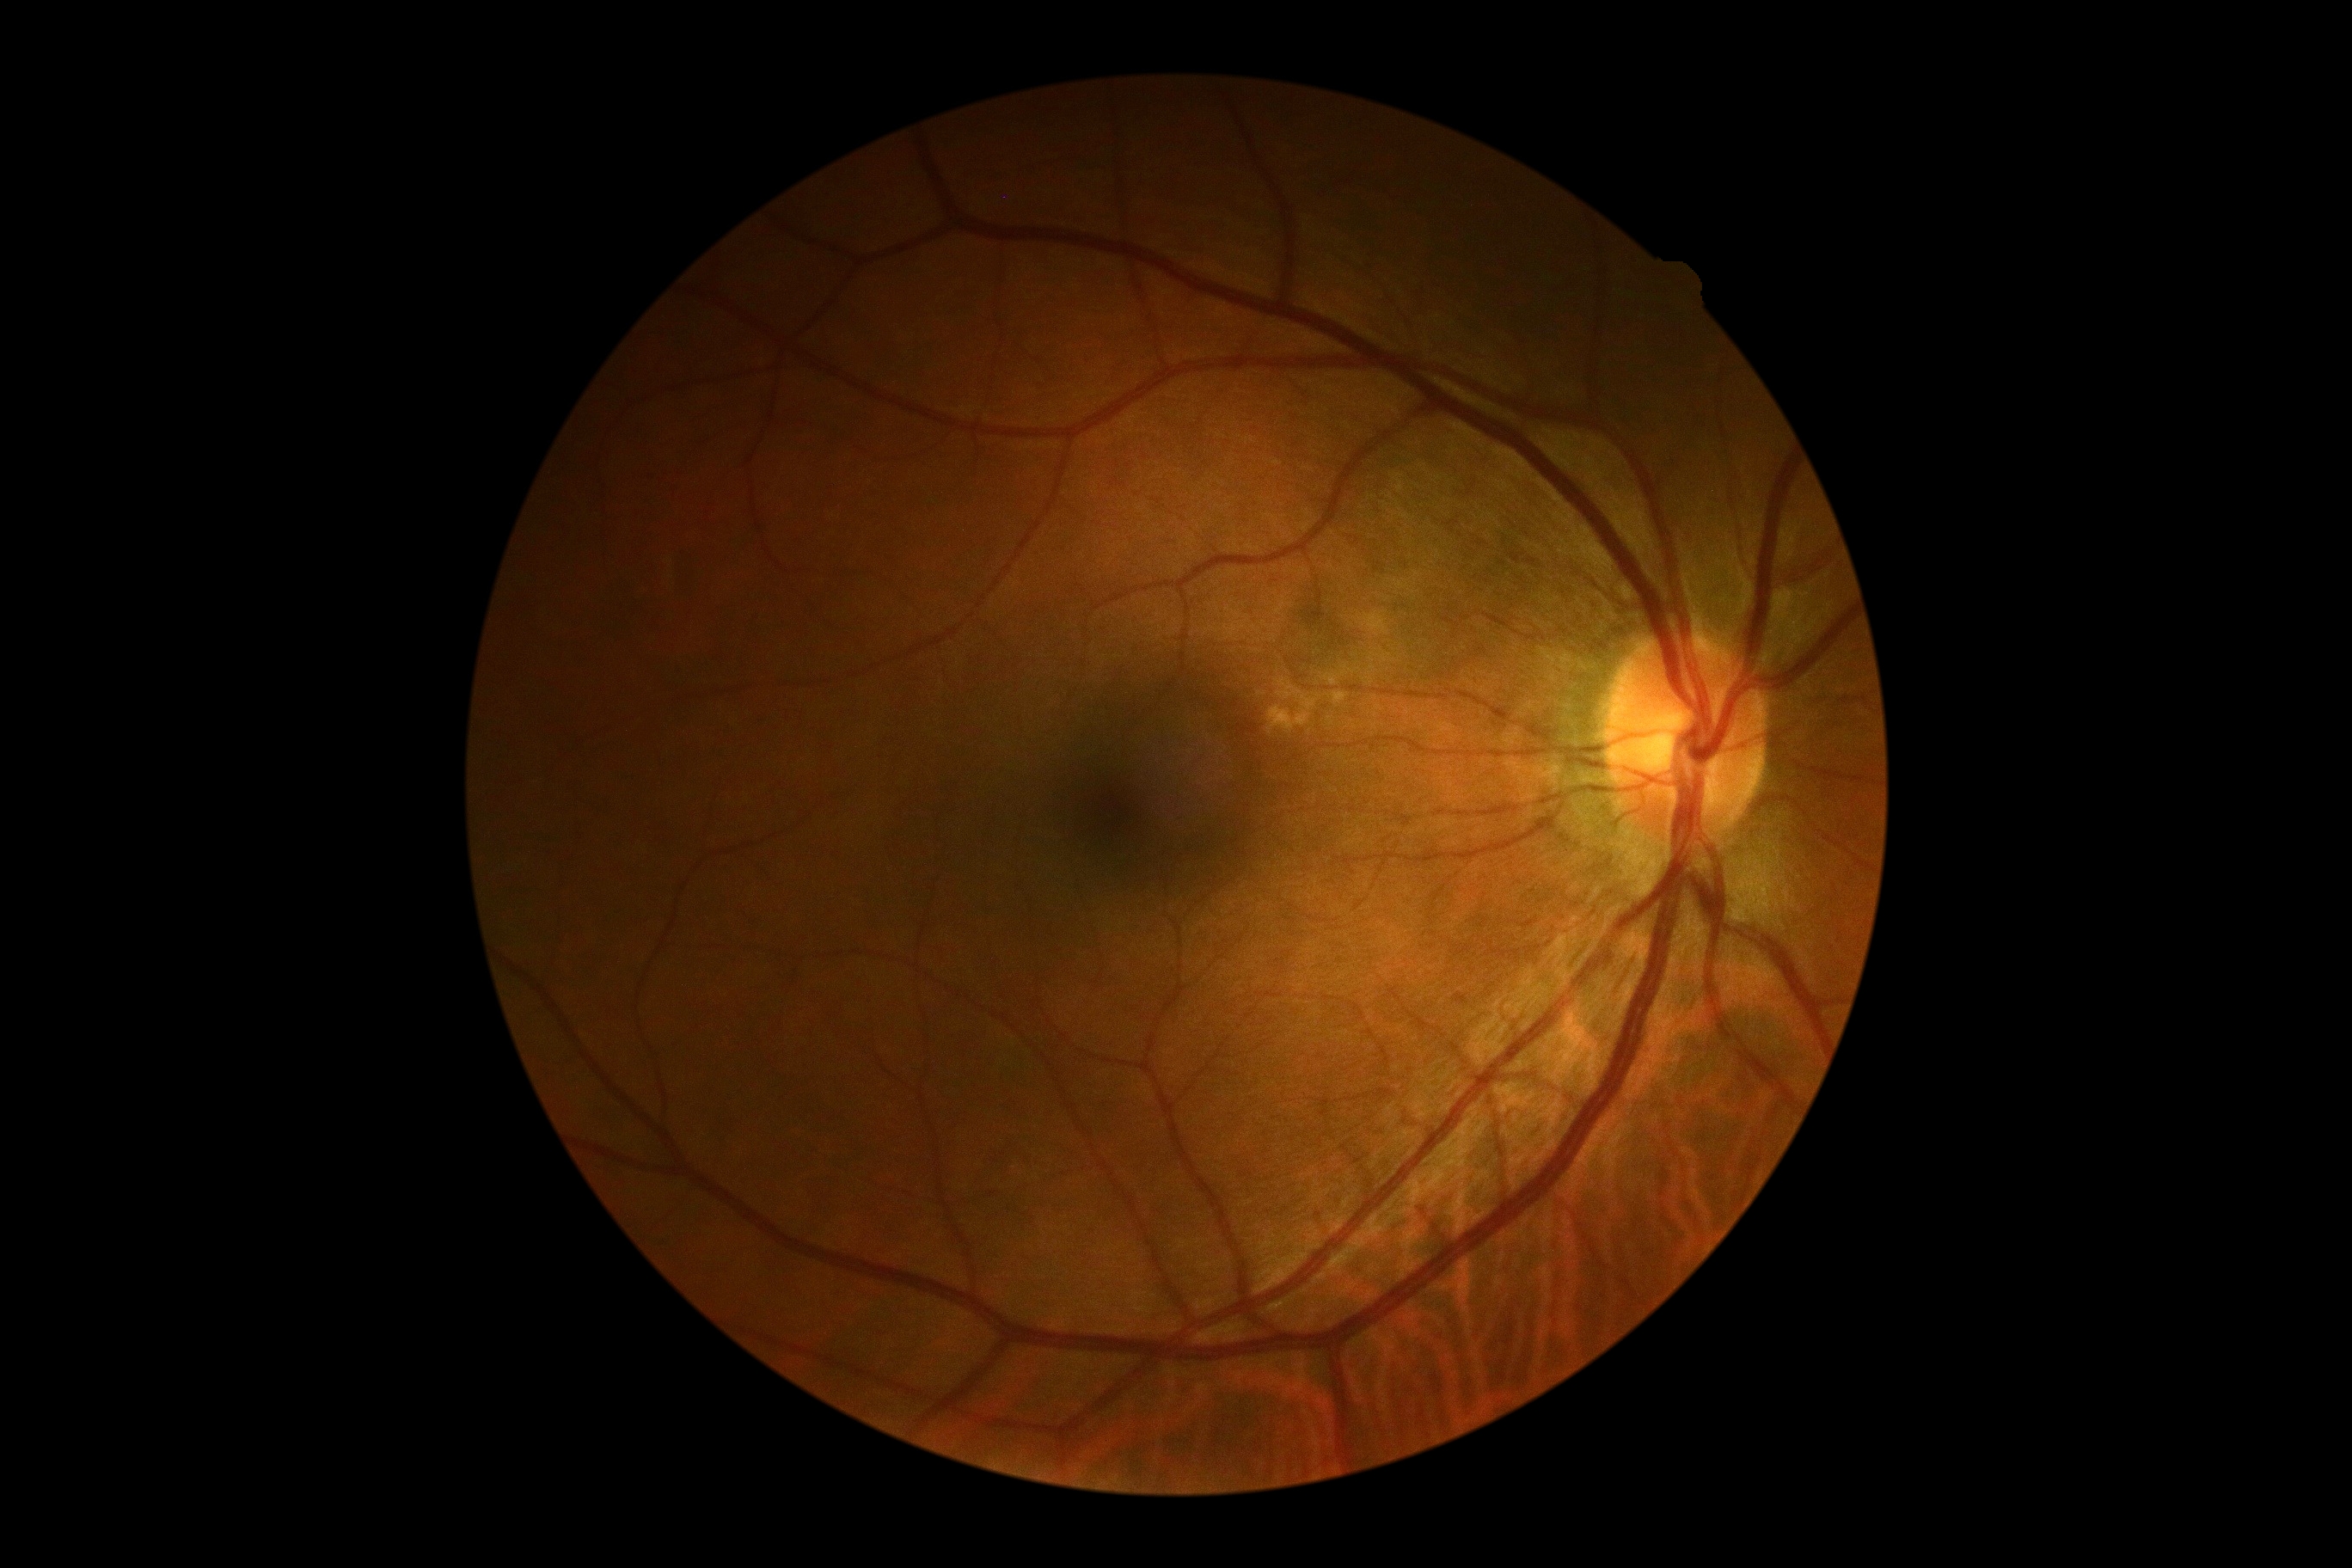 DR: grade 0. No diabetic retinal disease findings.